Retinal fundus photograph.
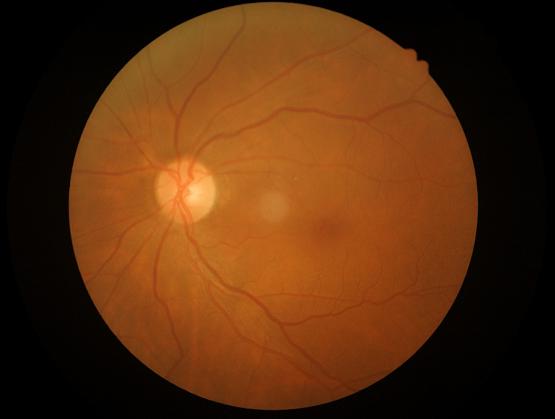
Vessels and details are readily distinguishable. No over- or under-exposure. Overall quality is good and the image is gradable.